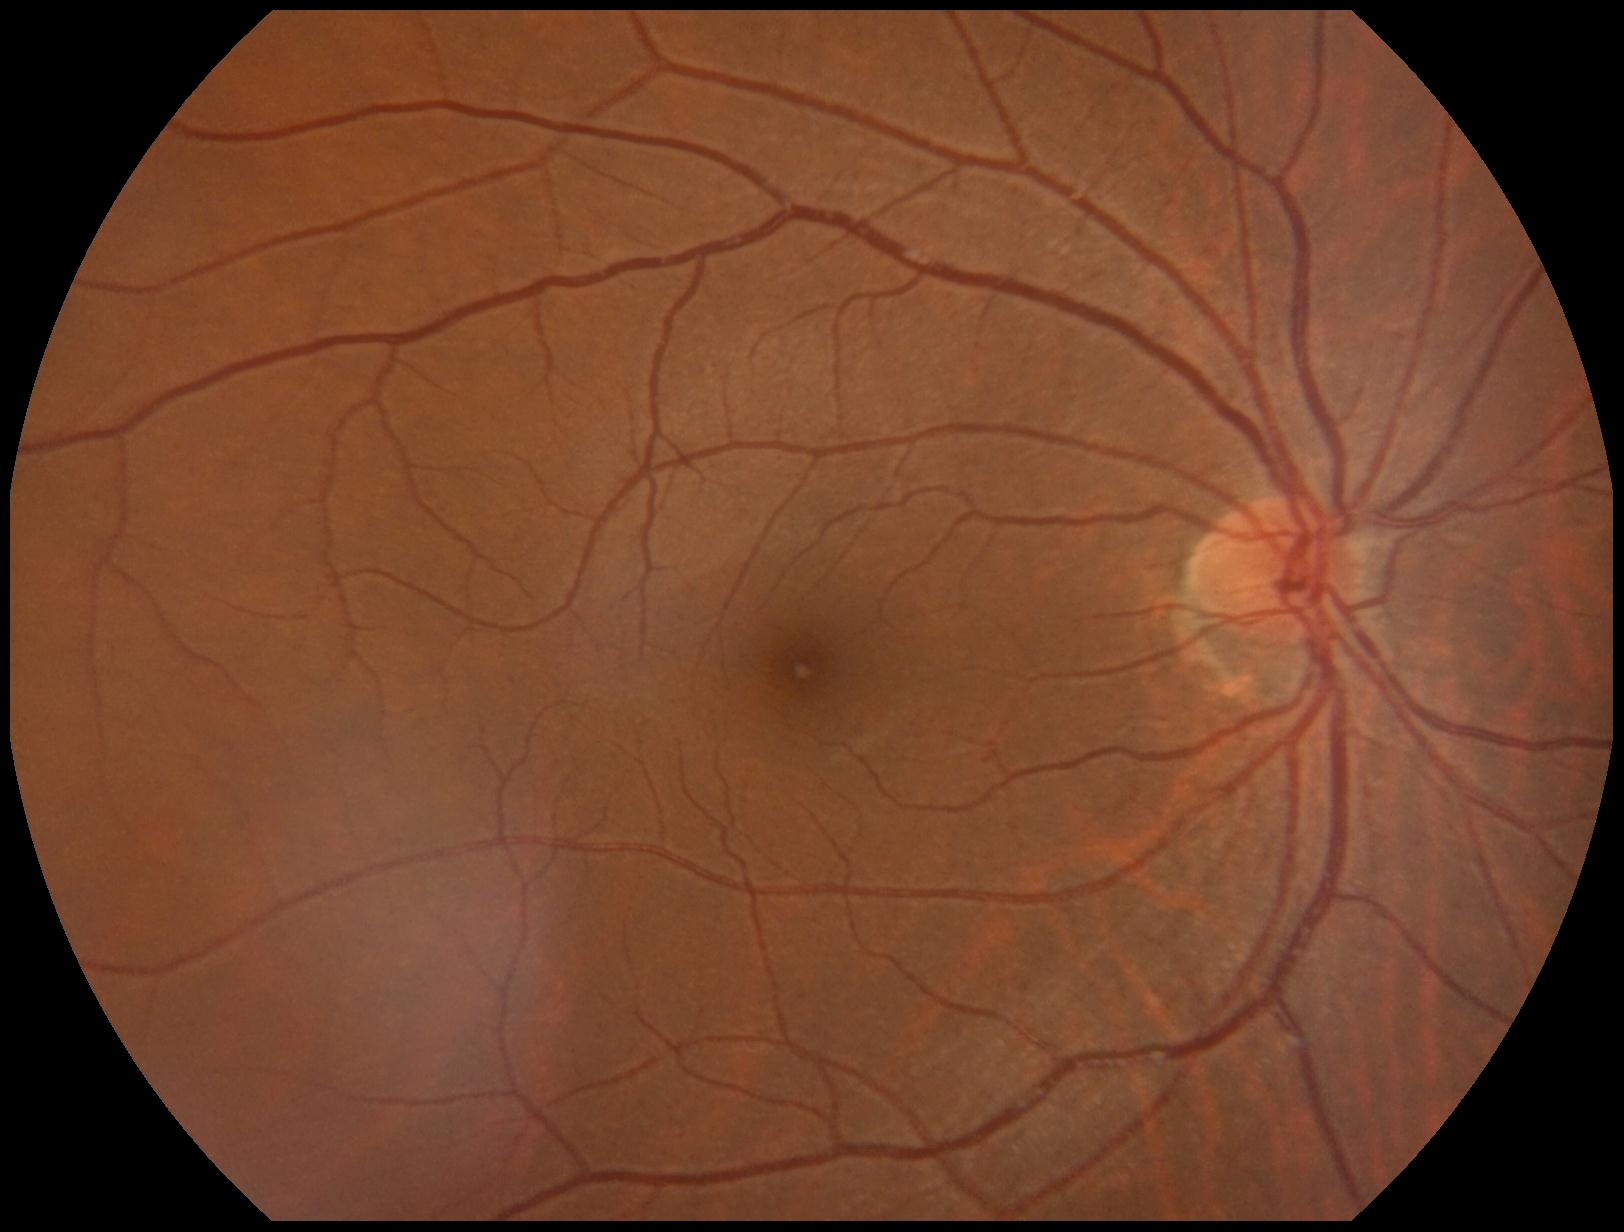

DR stage = grade 0 (no apparent retinopathy)